RetCam wide-field infant fundus image; Natus RetCam Envision, 130° FOV:
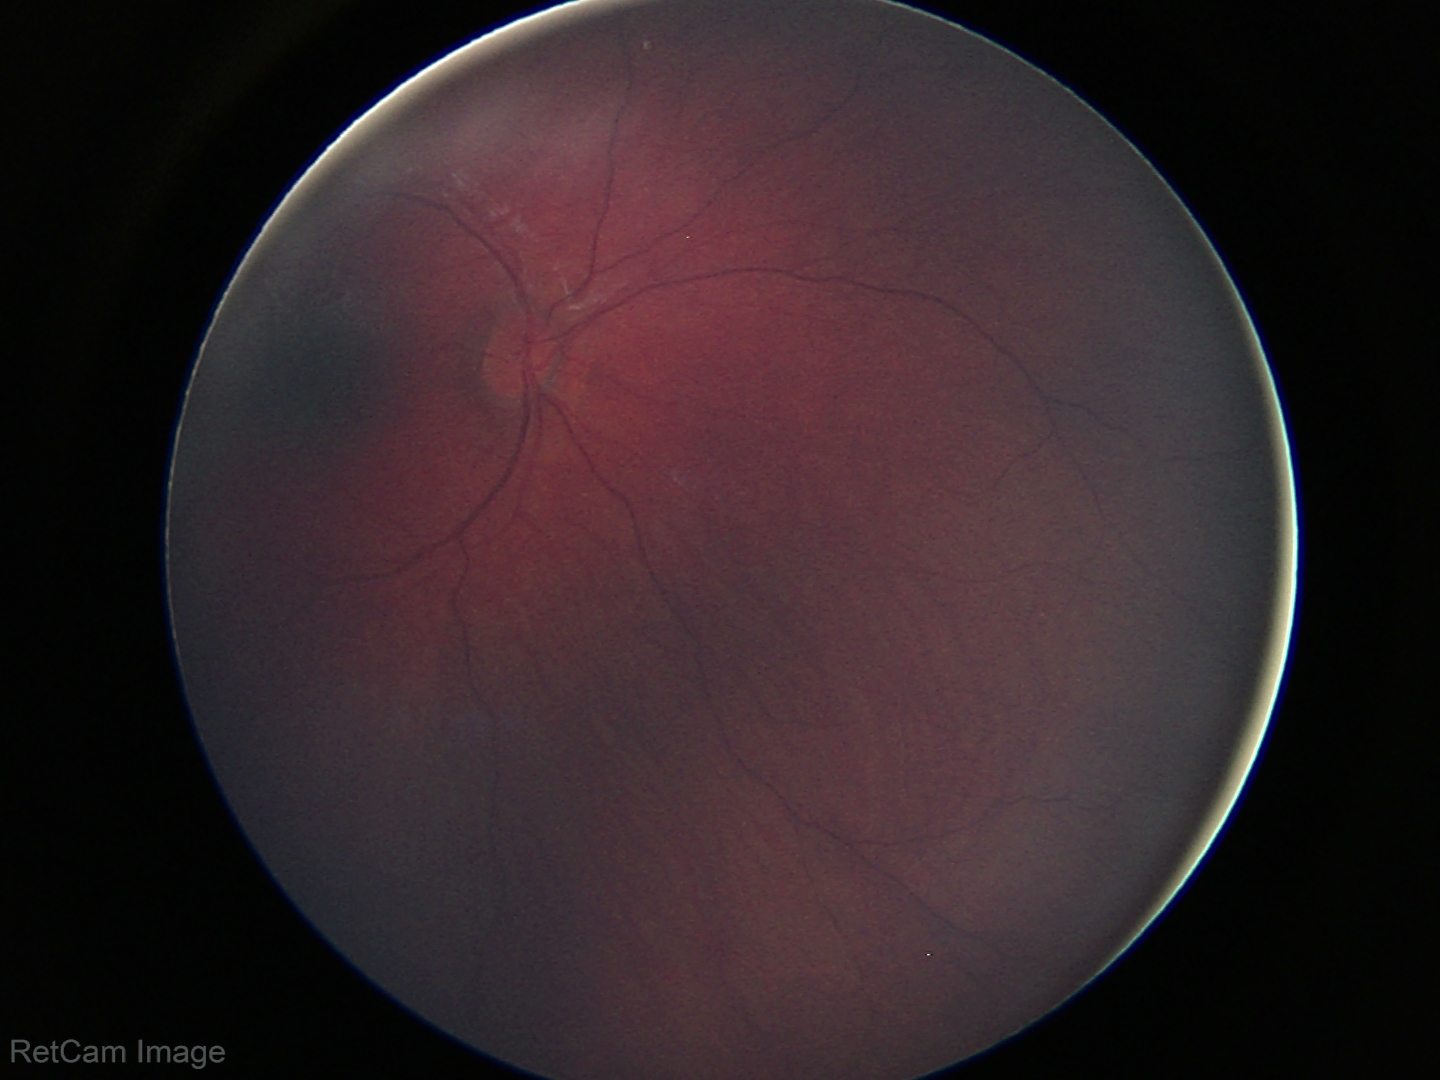 Examination with physiological retinal findings.